2352x1568px:
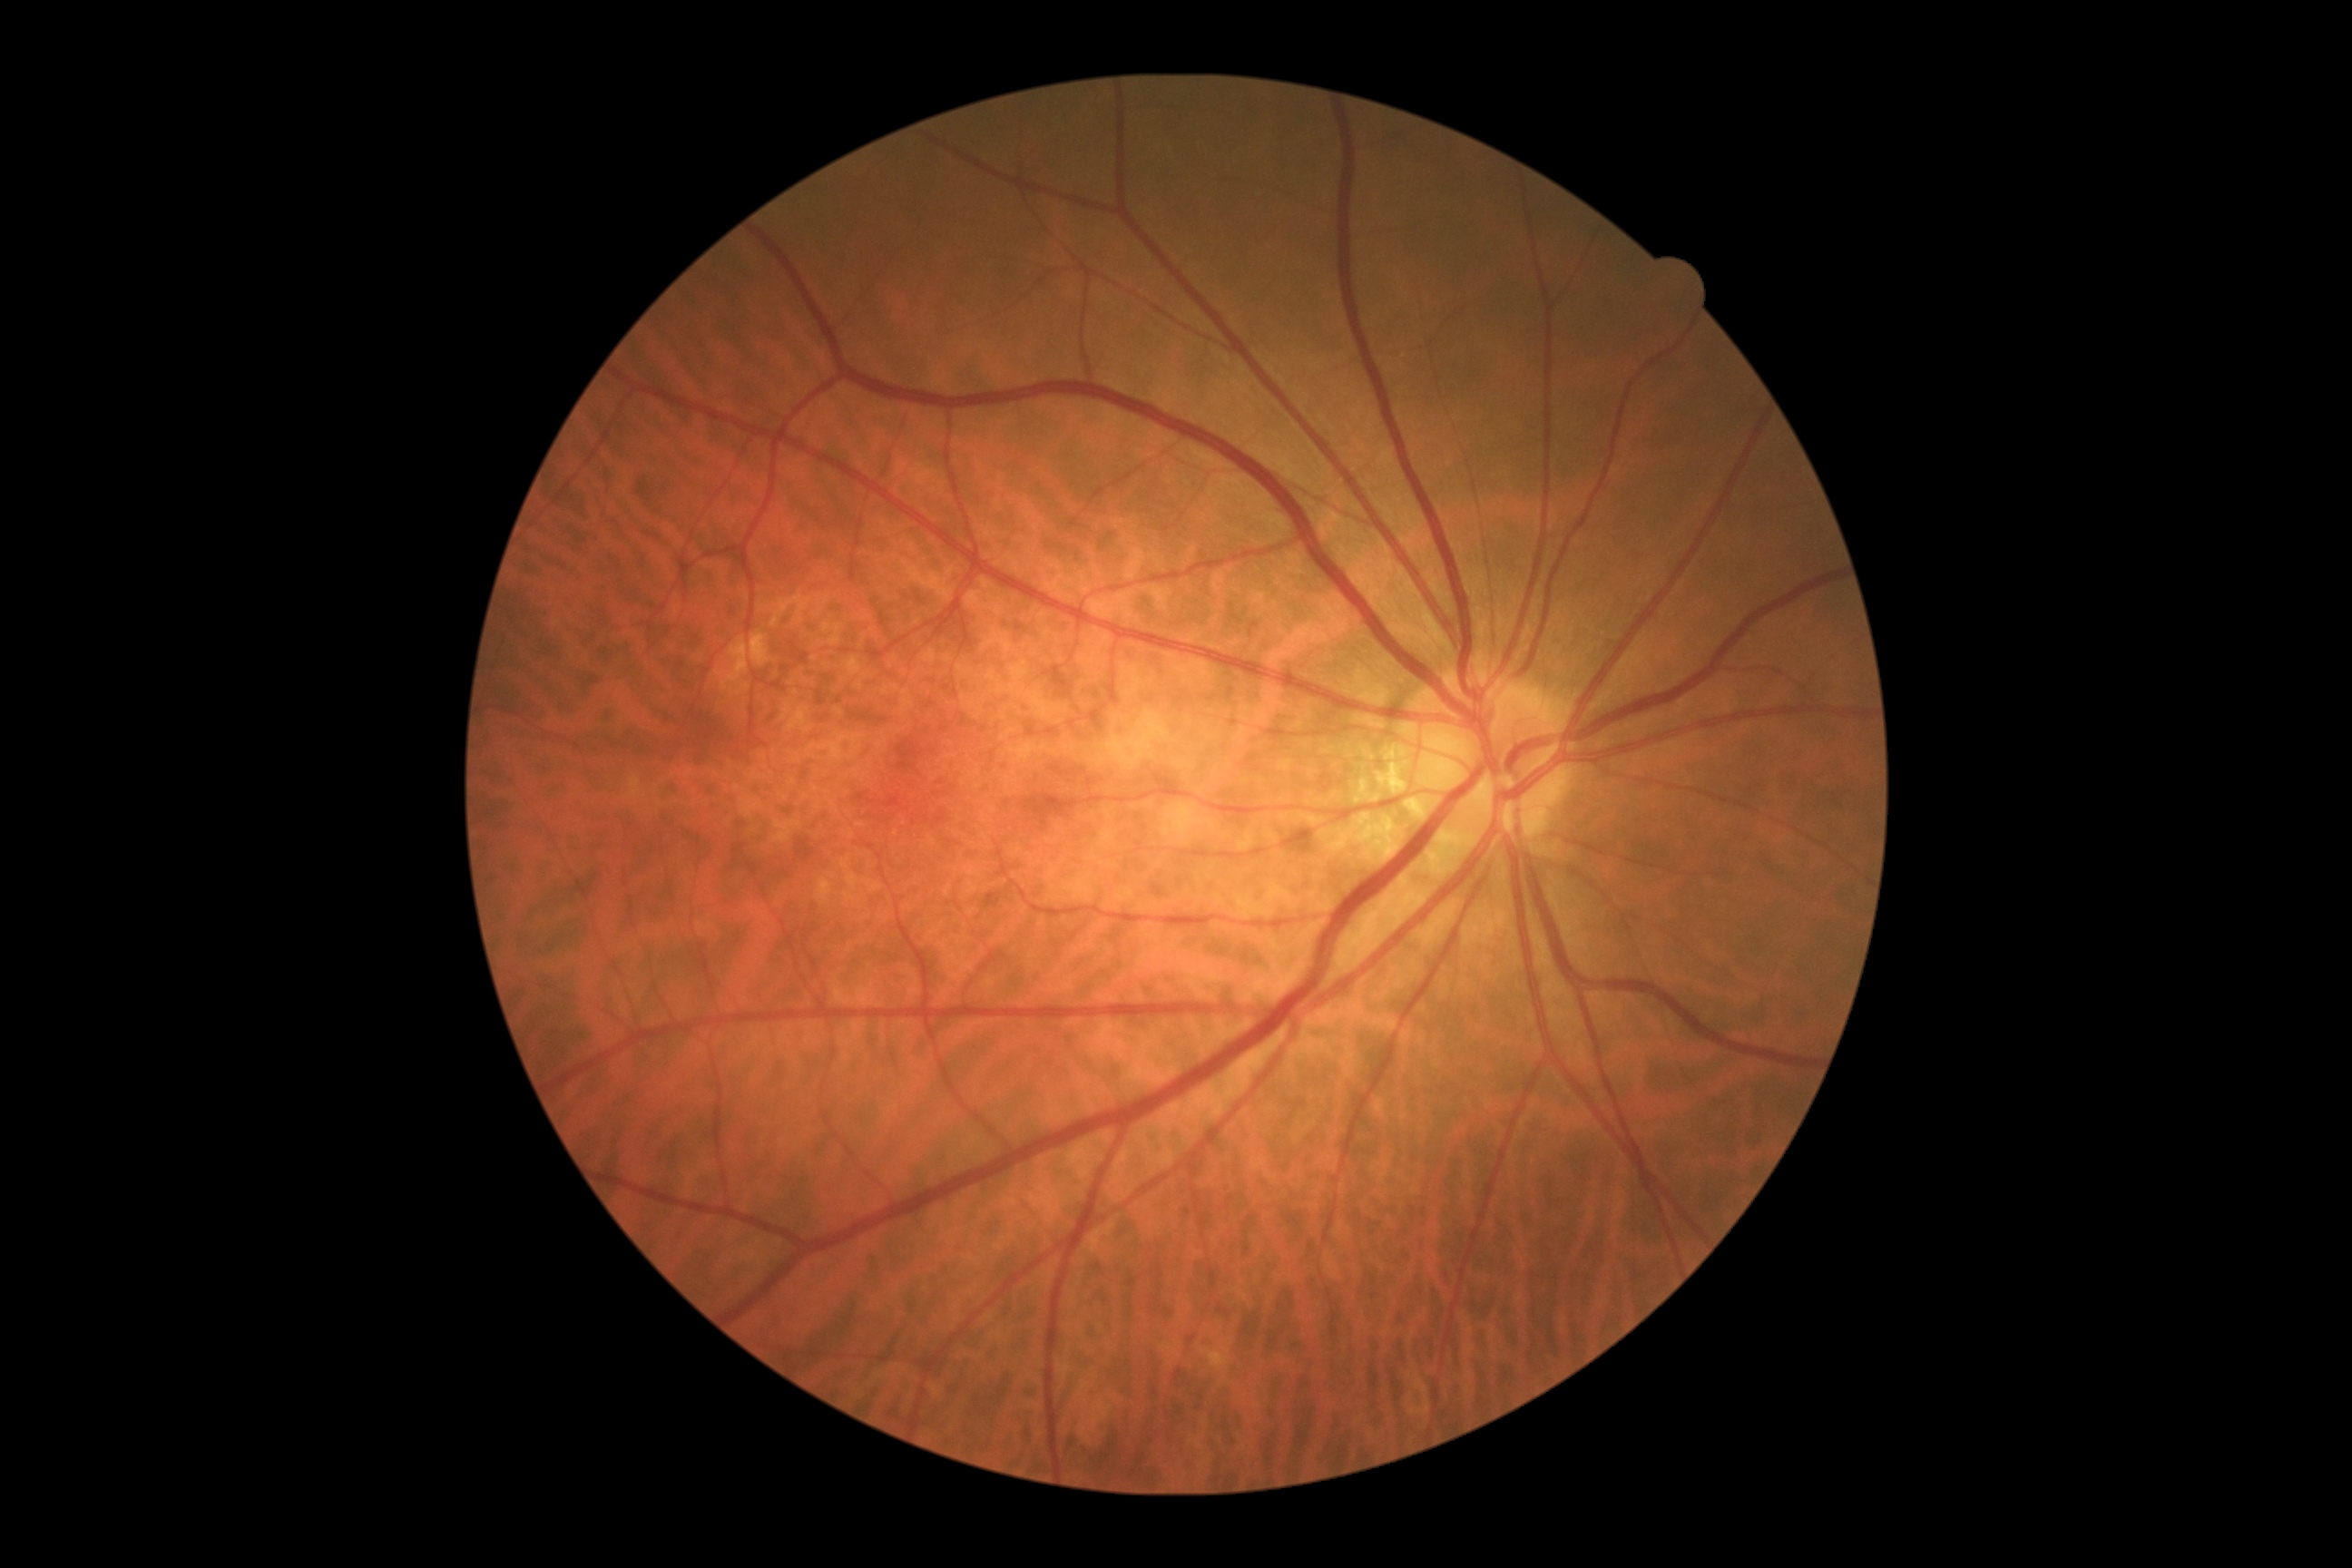

DR impression = no DR findings
DR grade = no apparent retinopathy (0)